Camera: NIDEK AFC-230 · 848 x 848 pixels · retinal fundus photograph · nonmydriatic: 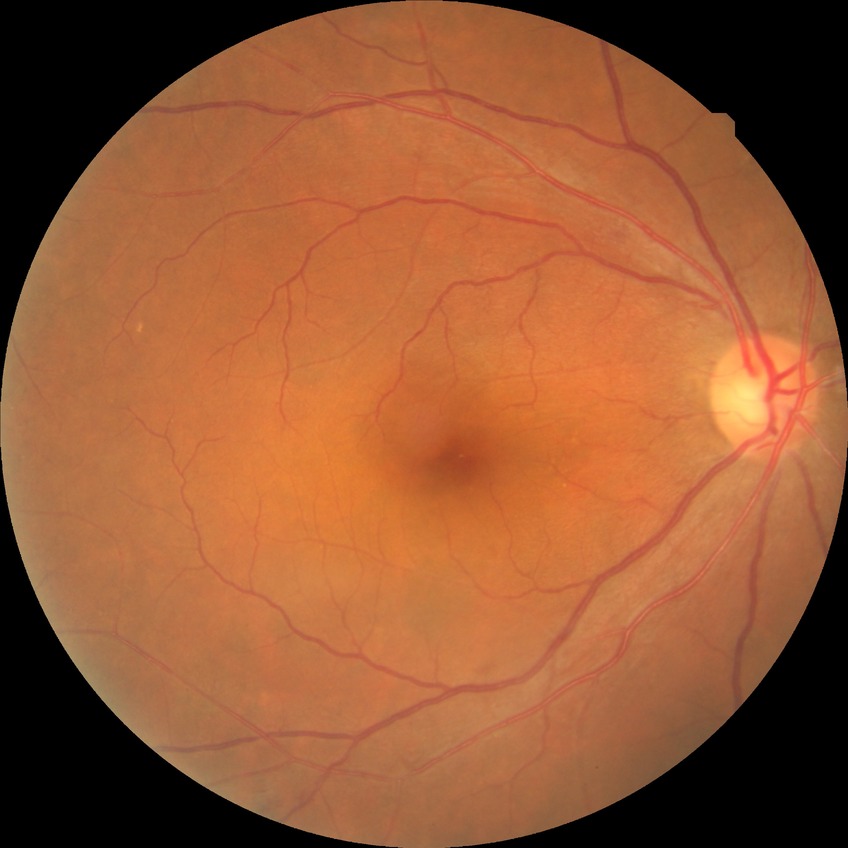 Davis grade: SDR. DR class: non-proliferative diabetic retinopathy.